Fundus photo
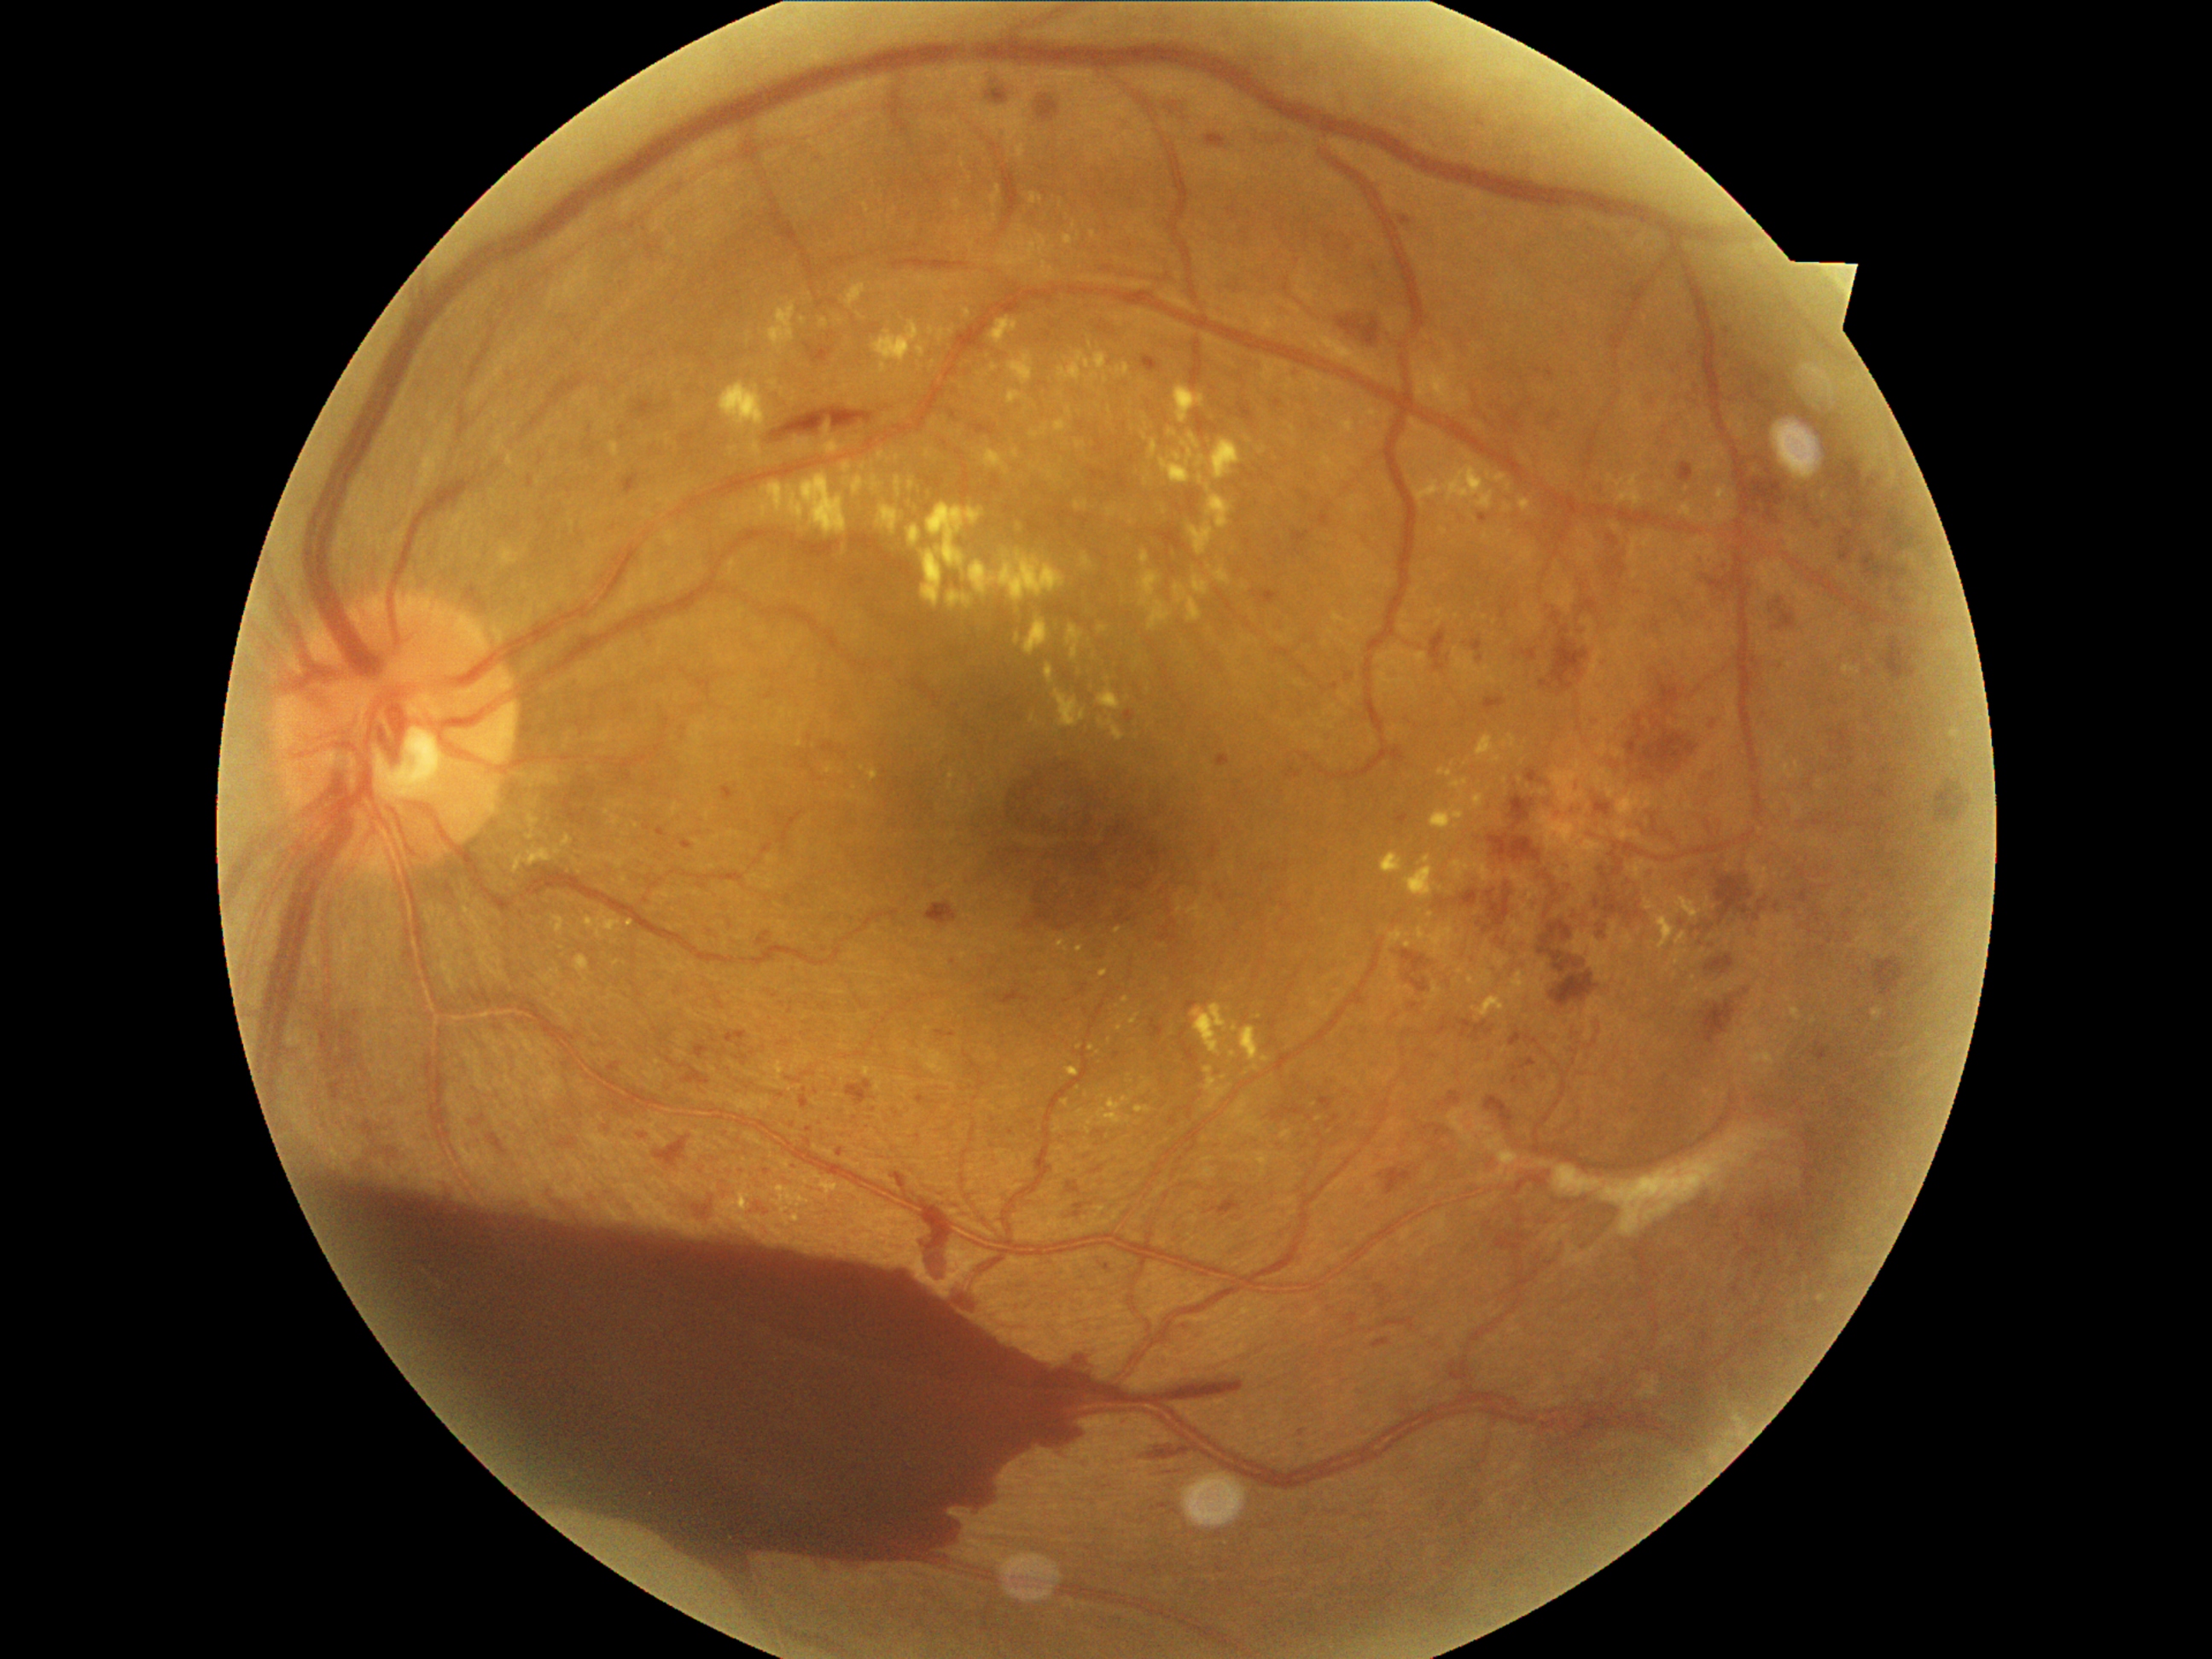

Diabetic retinopathy (DR): 4/4
Lesions identified (partial list):
microaneurysms (MAs) (more not shown): rect(1522, 1059, 1537, 1069); rect(1802, 890, 1810, 902); rect(1078, 984, 1088, 994); rect(1284, 764, 1305, 779); rect(1759, 897, 1767, 912); rect(1317, 1097, 1334, 1112); rect(620, 428, 626, 438); rect(992, 989, 1032, 1006); rect(800, 1097, 812, 1110); rect(489, 1134, 503, 1151); rect(791, 1161, 798, 1172); rect(1452, 1359, 1470, 1382); rect(1549, 414, 1556, 426); rect(1831, 730, 1851, 755)
Additional small MAs near <point>1523, 407</point>; <point>1601, 935</point>; <point>1777, 905</point>; <point>793, 1125</point>; <point>1531, 404</point>; <point>1298, 376</point>
hard exudates (EXs) (more not shown): rect(1196, 455, 1208, 469); rect(1749, 1051, 1776, 1074); rect(1109, 508, 1119, 518); rect(1062, 1100, 1069, 1109); rect(1429, 806, 1465, 832); rect(1011, 450, 1020, 458); rect(955, 201, 963, 211); rect(992, 214, 998, 223); rect(1057, 351, 1107, 381); rect(871, 322, 921, 375); rect(895, 475, 904, 498); rect(1032, 424, 1049, 439); rect(1452, 779, 1469, 803); rect(870, 769, 880, 781)
Additional small EXs near <point>1457, 827</point>; <point>1409, 936</point>; <point>1079, 949</point>; <point>1245, 588</point>; <point>1432, 915</point>